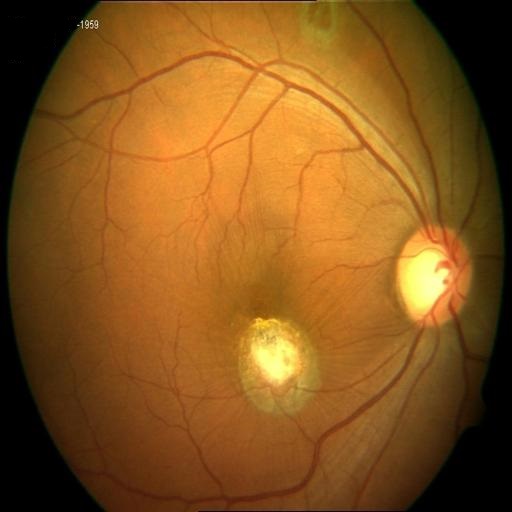 Pathology: chorioretinitis, choroidal folds, macular scar.